200° field of view, ultra-widefield fundus photograph, 1924 by 1556 pixels.
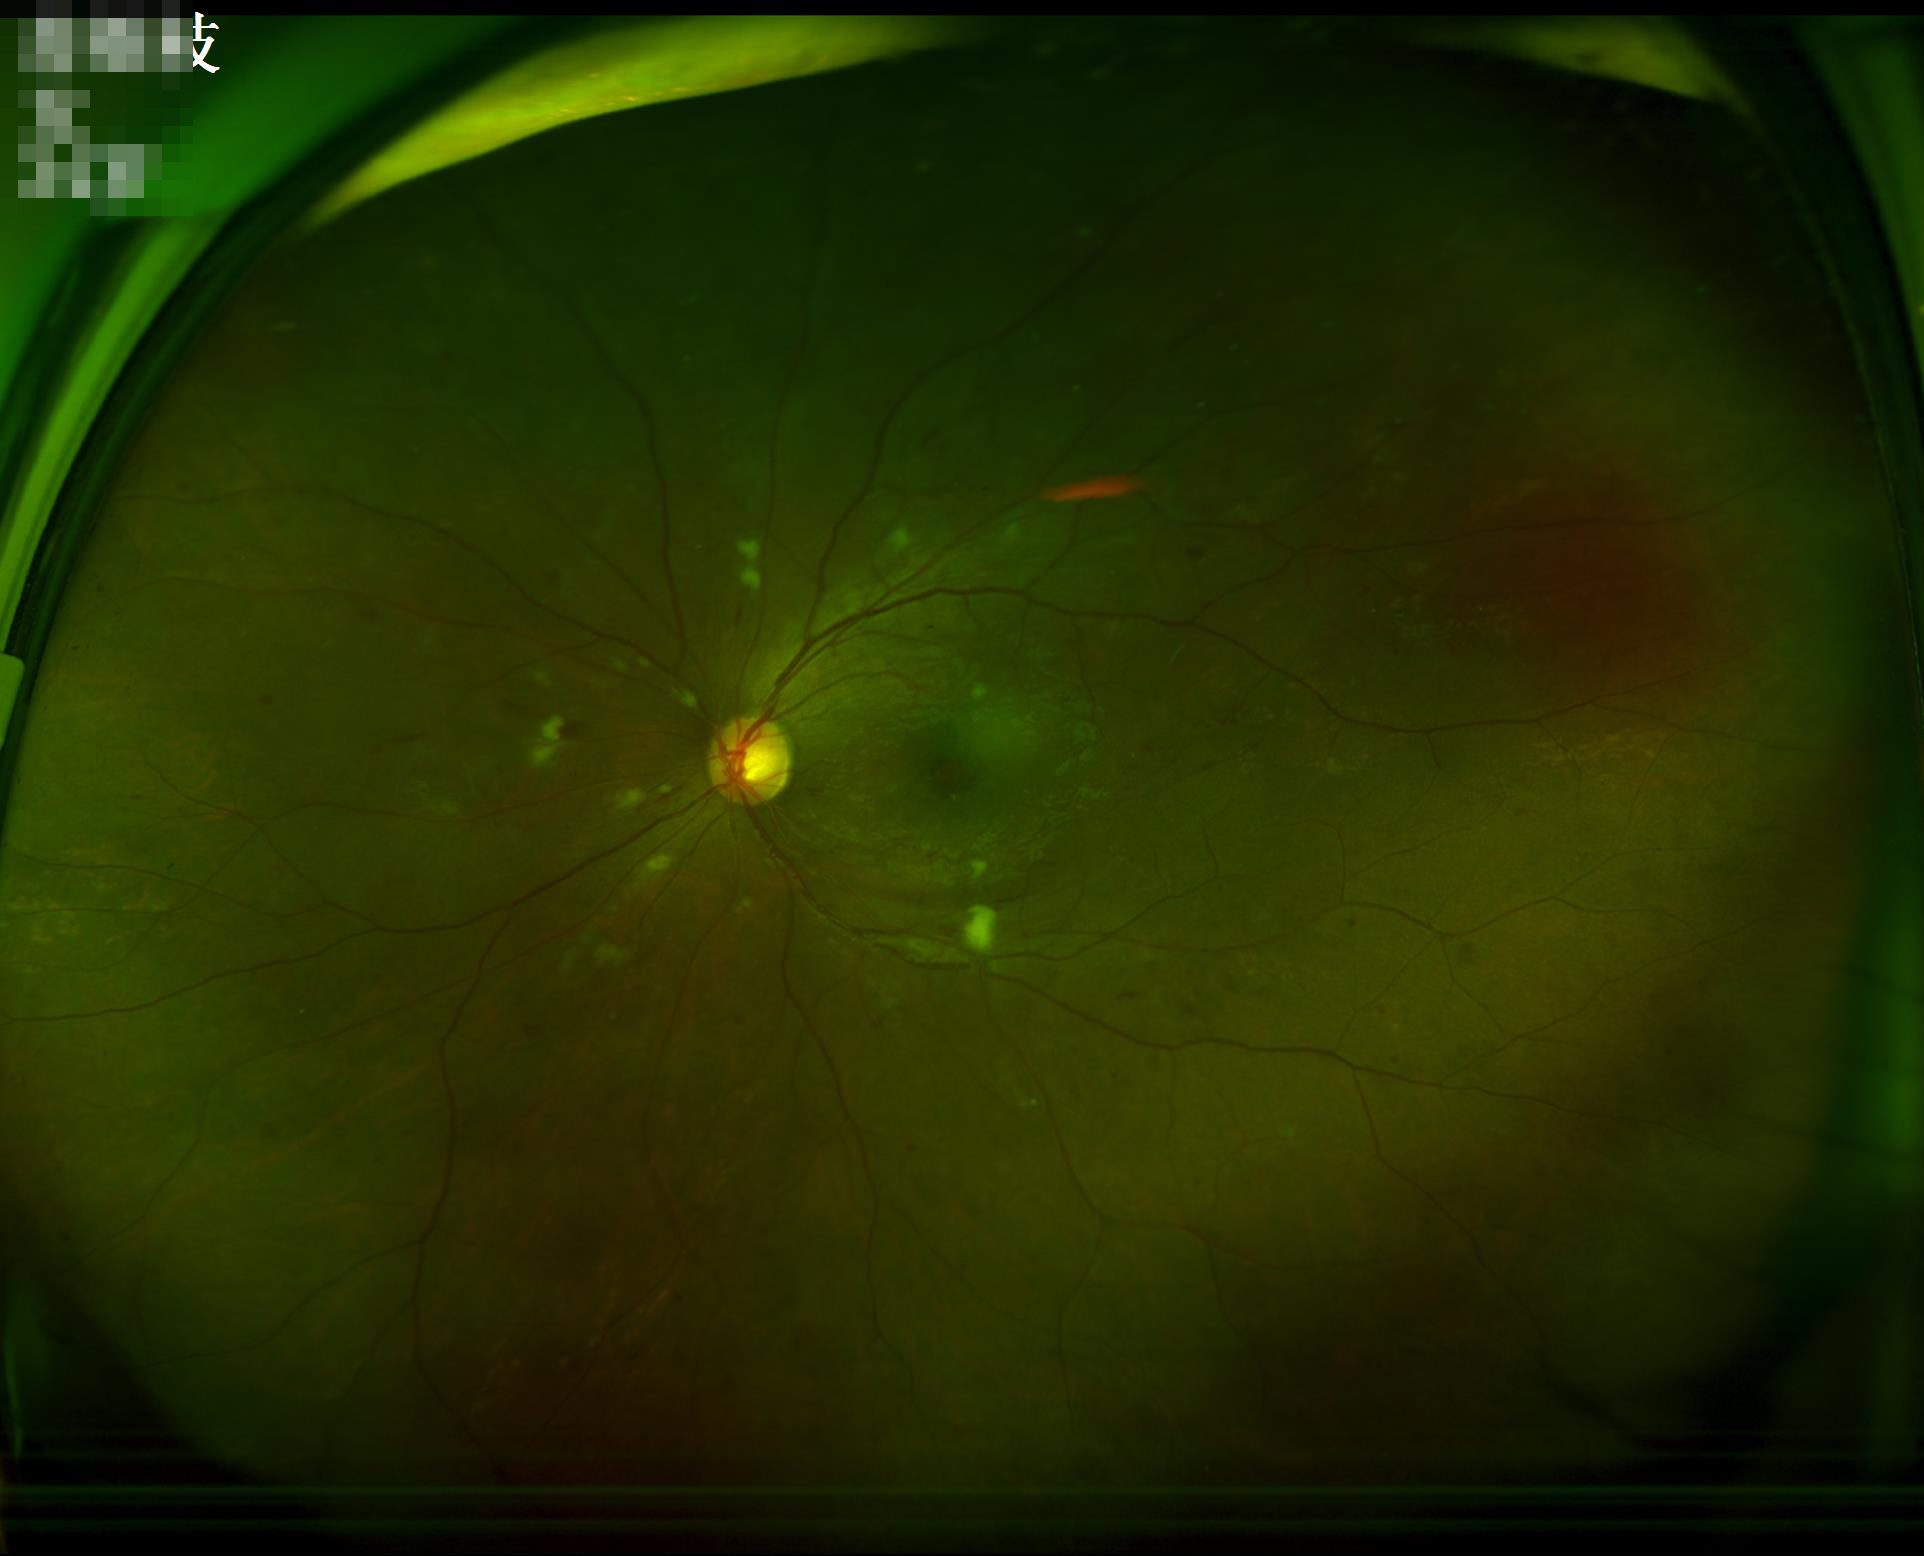

{"contrast": "vessels and details readily distinguishable", "overall_quality": "good and suitable for diagnostic use", "illumination": "good illumination and color balance"}